Modified Davis classification
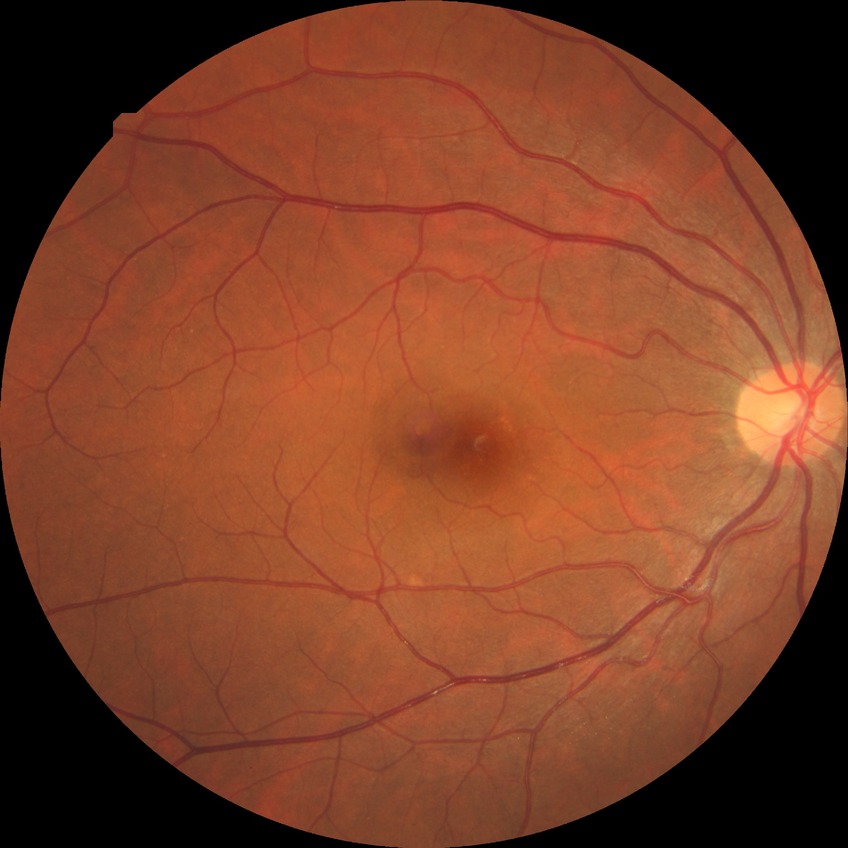 Findings:
• diabetic retinopathy (DR) — no diabetic retinopathy (NDR)